Wide-field contact fundus photograph of an infant · camera: Clarity RetCam 3 (130° FOV)
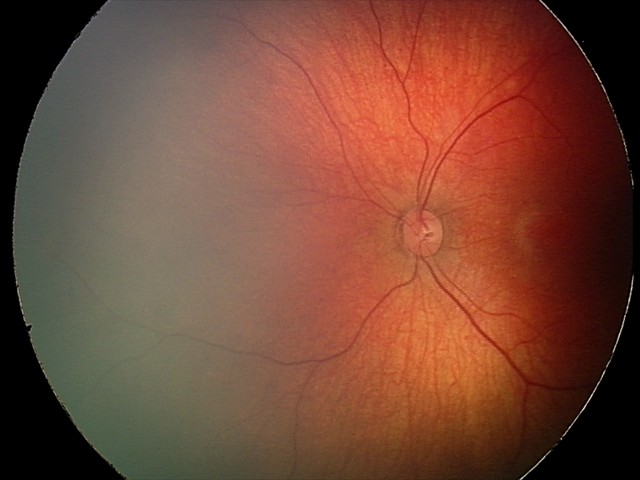 Impression = retinal hemorrhages